FOV: 45 degrees; fundus photo; 1932x1916px:
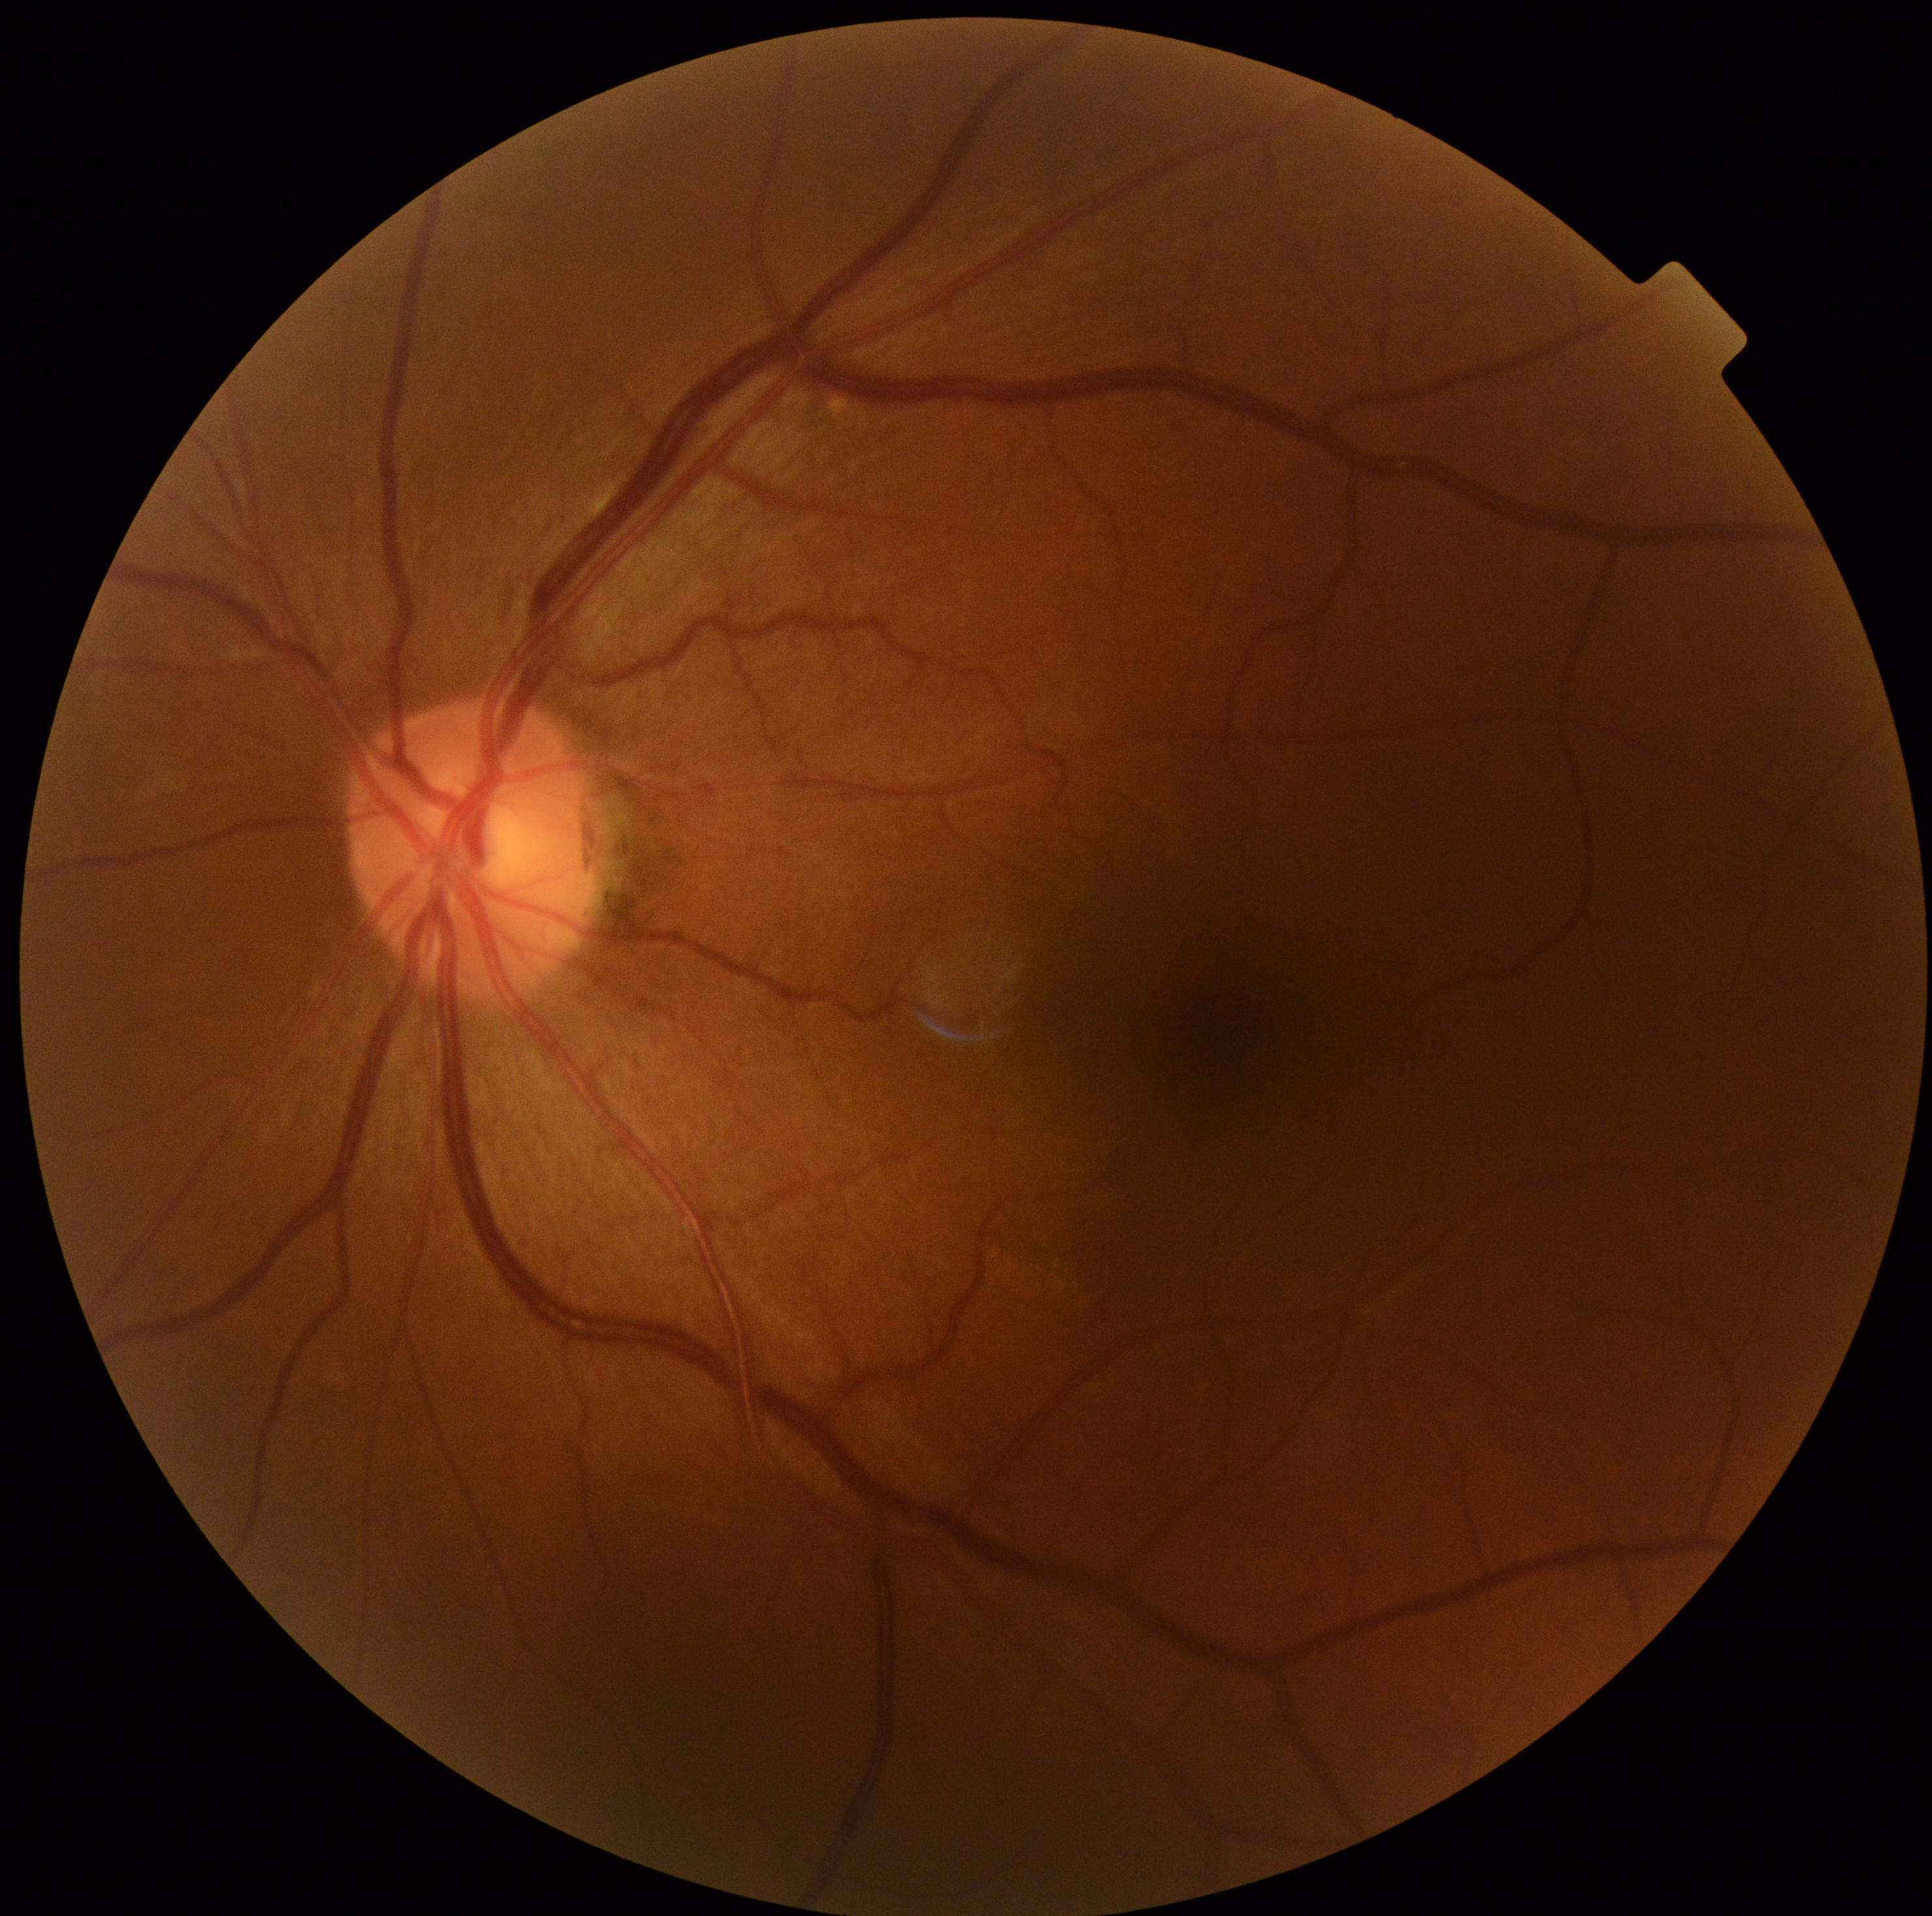

Annotations:
- diabetic retinopathy (DR) — no apparent diabetic retinopathy (grade 0)
- DR impression — no apparent DR